2346x1568px · 45° FOV:
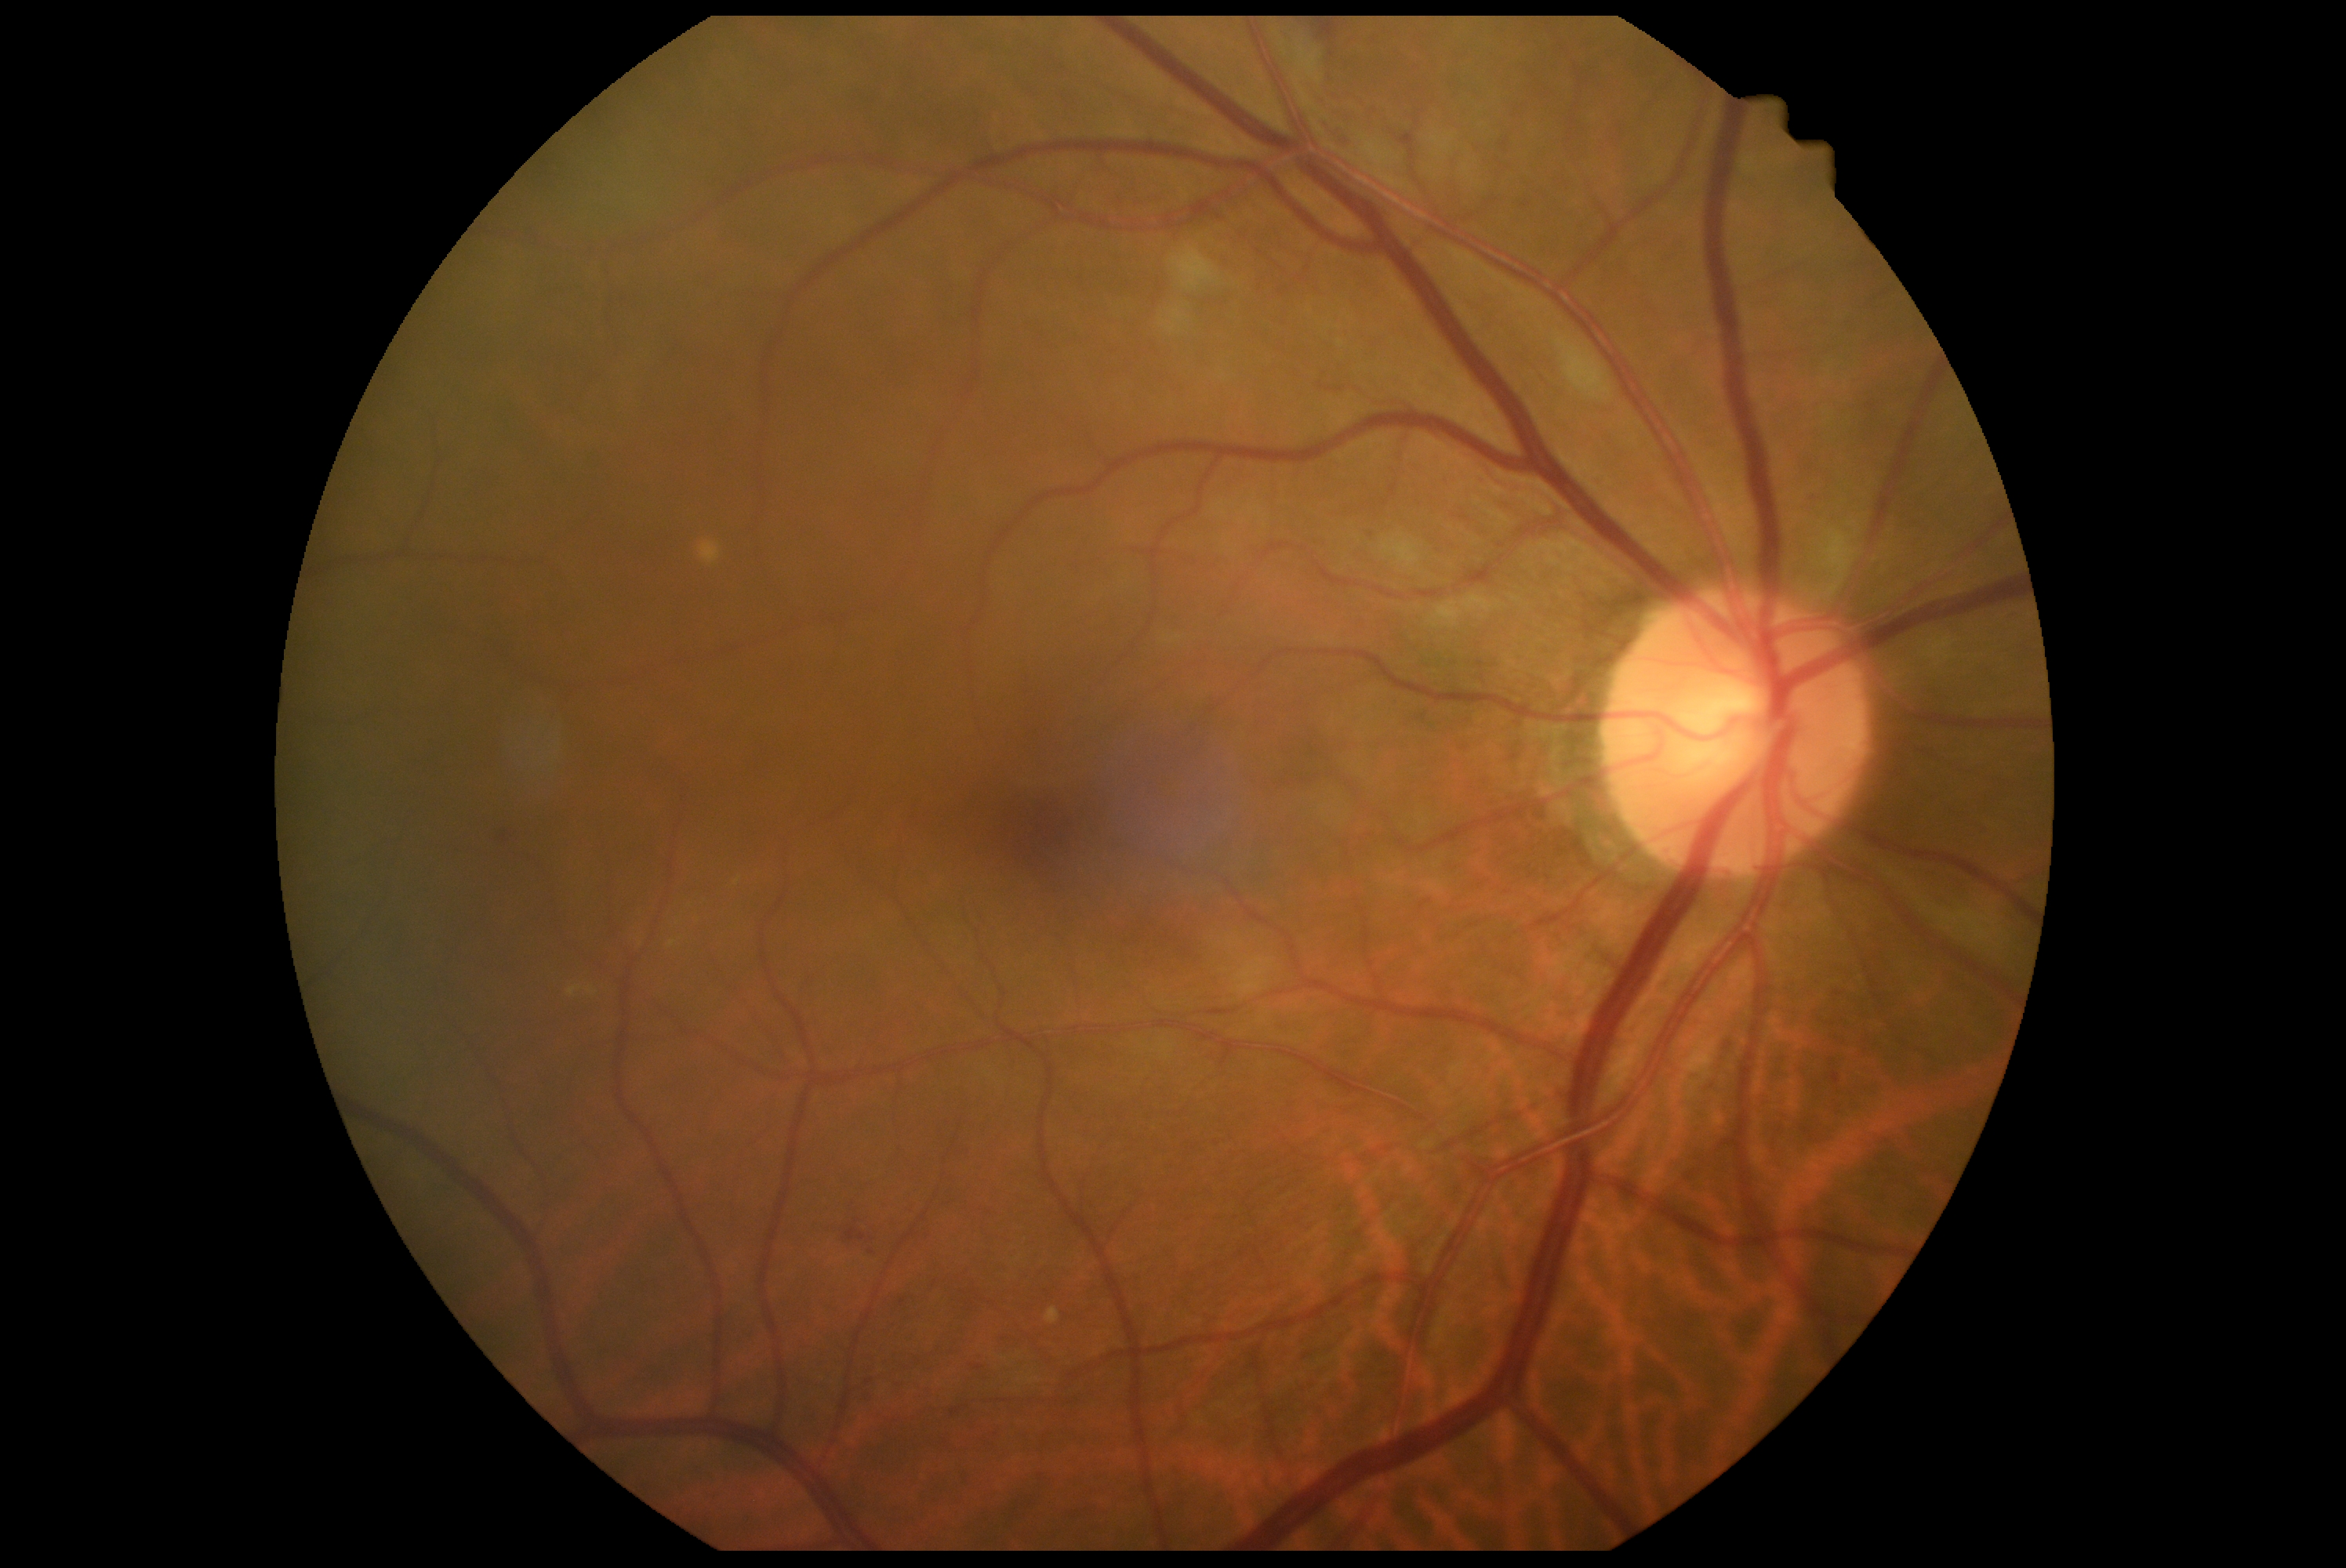 DR severity: moderate NPDR (grade 2) — more than just microaneurysms but less than severe NPDR.